Without pupil dilation, Davis DR grading:
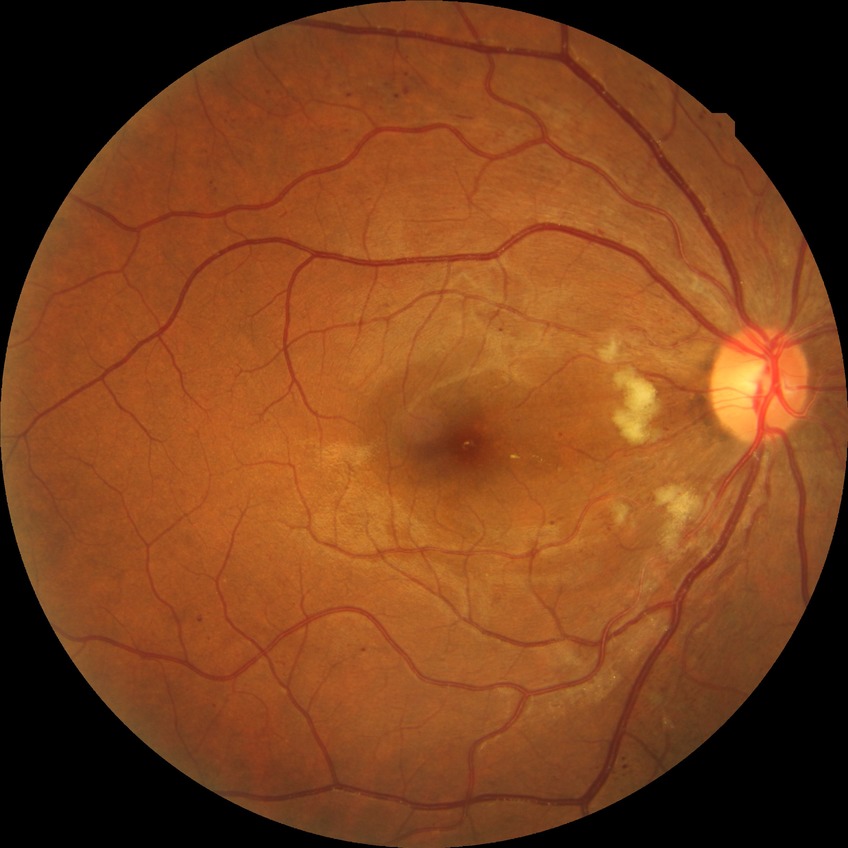
Findings:
– diabetic retinopathy (DR) — pre-proliferative diabetic retinopathy (PPDR)